CFP; acquired with a Nidek AFC-330; disc-centered field — 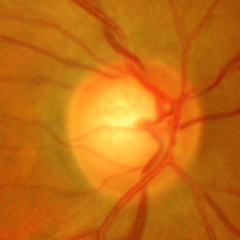 Glaucomatous optic neuropathy is present. Glaucoma stage: advanced glaucomatous optic neuropathy.